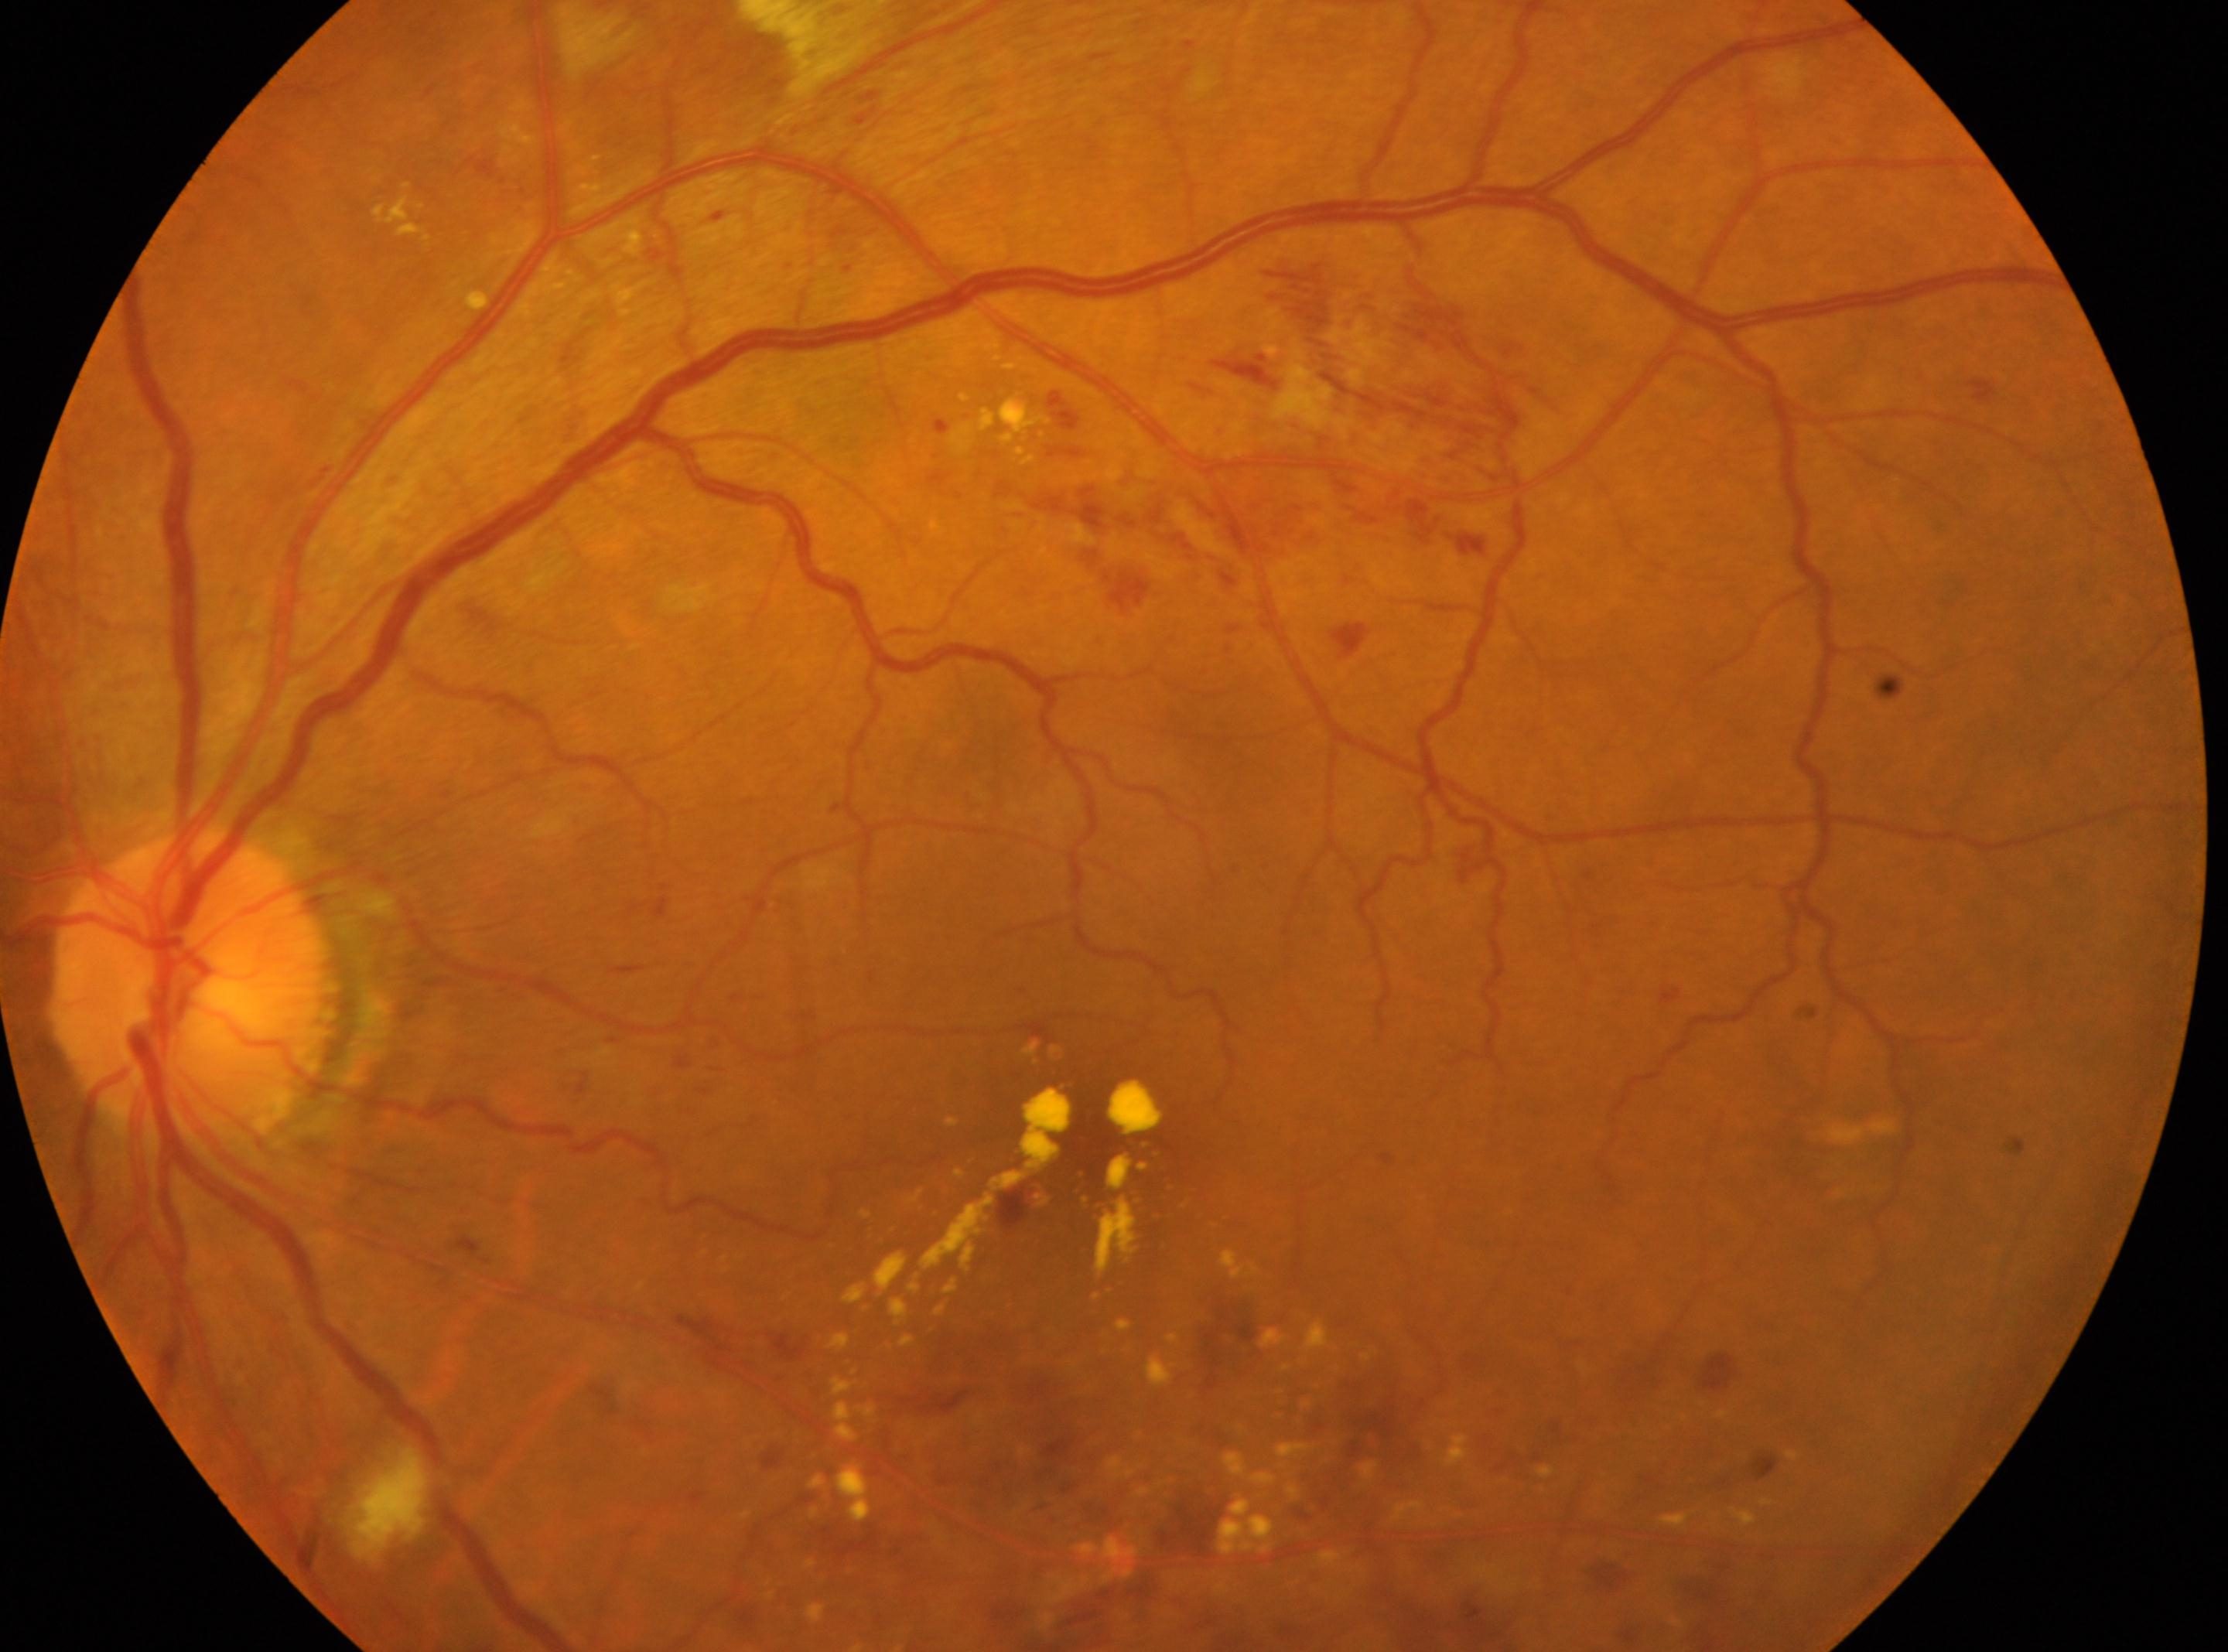
| key | value |
|---|---|
| foveal center | (x=1086, y=1186) |
| diabetic retinopathy (DR) | grade 3 (severe NPDR) — more than 20 intraretinal hemorrhages in each of 4 quadrants, definite venous beading in 2 or more quadrants, or prominent intraretinal microvascular abnormalities in 1 or more quadrants, with no signs of proliferative retinopathy |
| laterality | left |
| ONH | (x=189, y=985) |